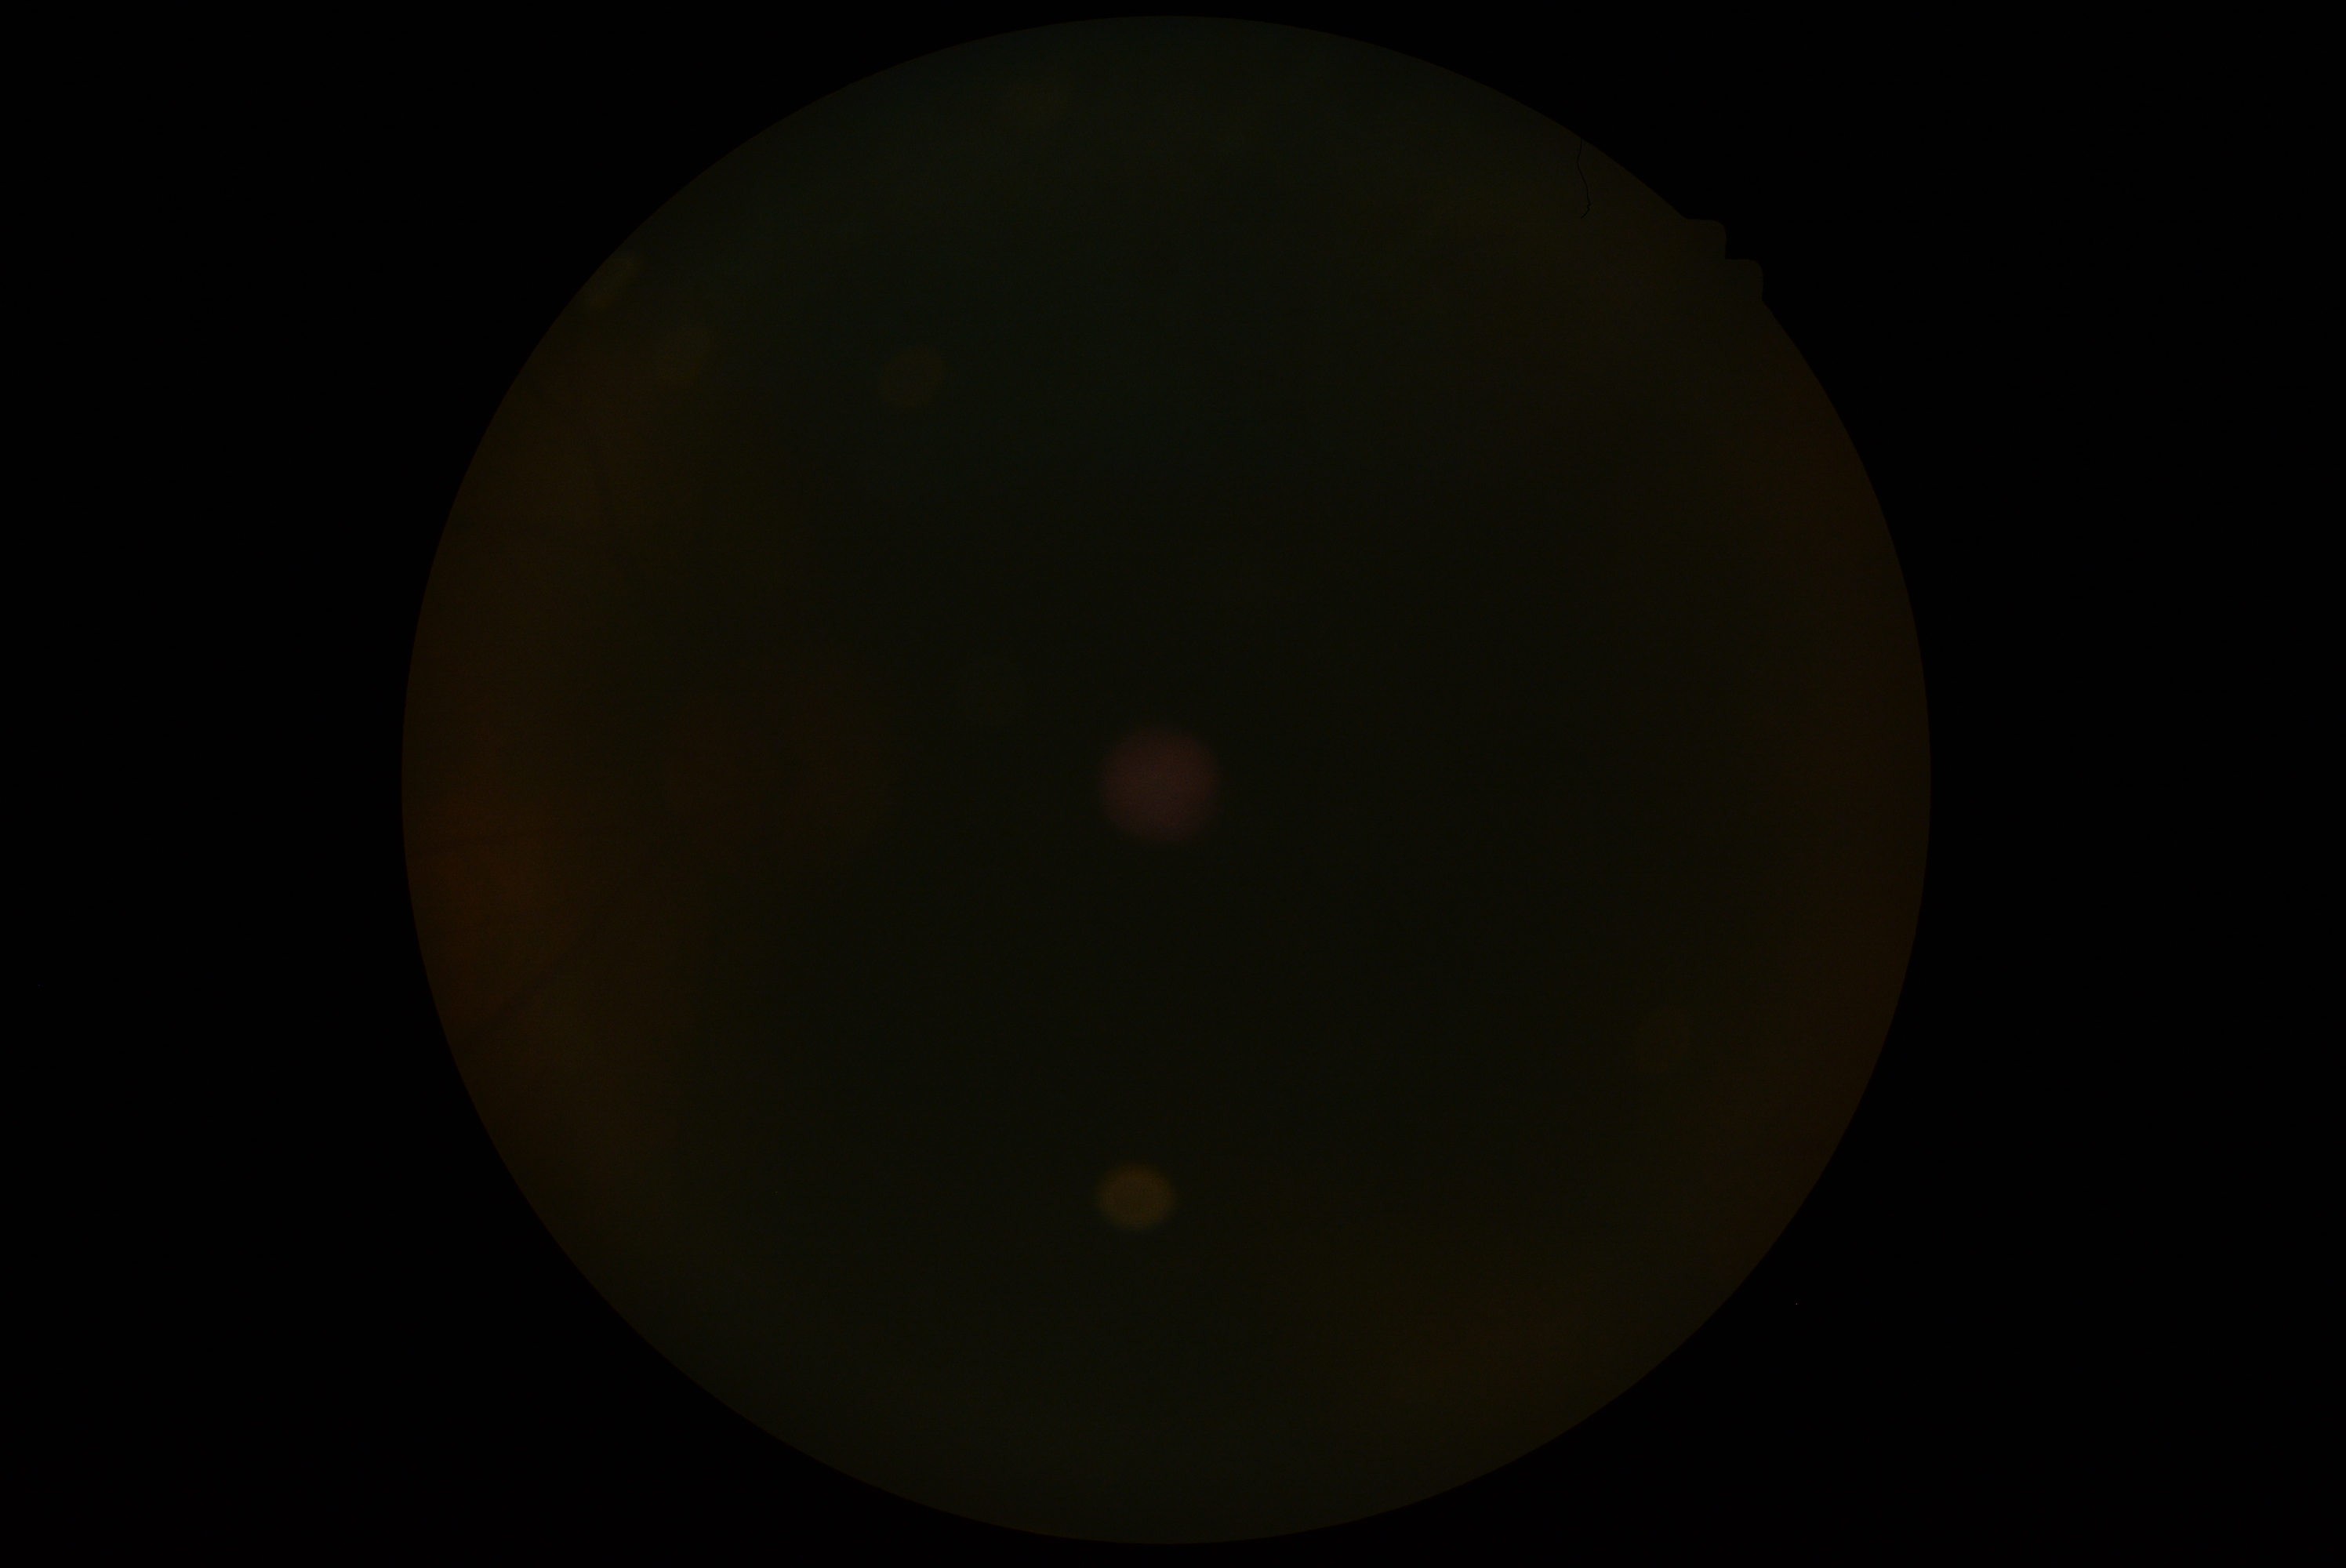
• DR stage: ungradable
• image quality: insufficient